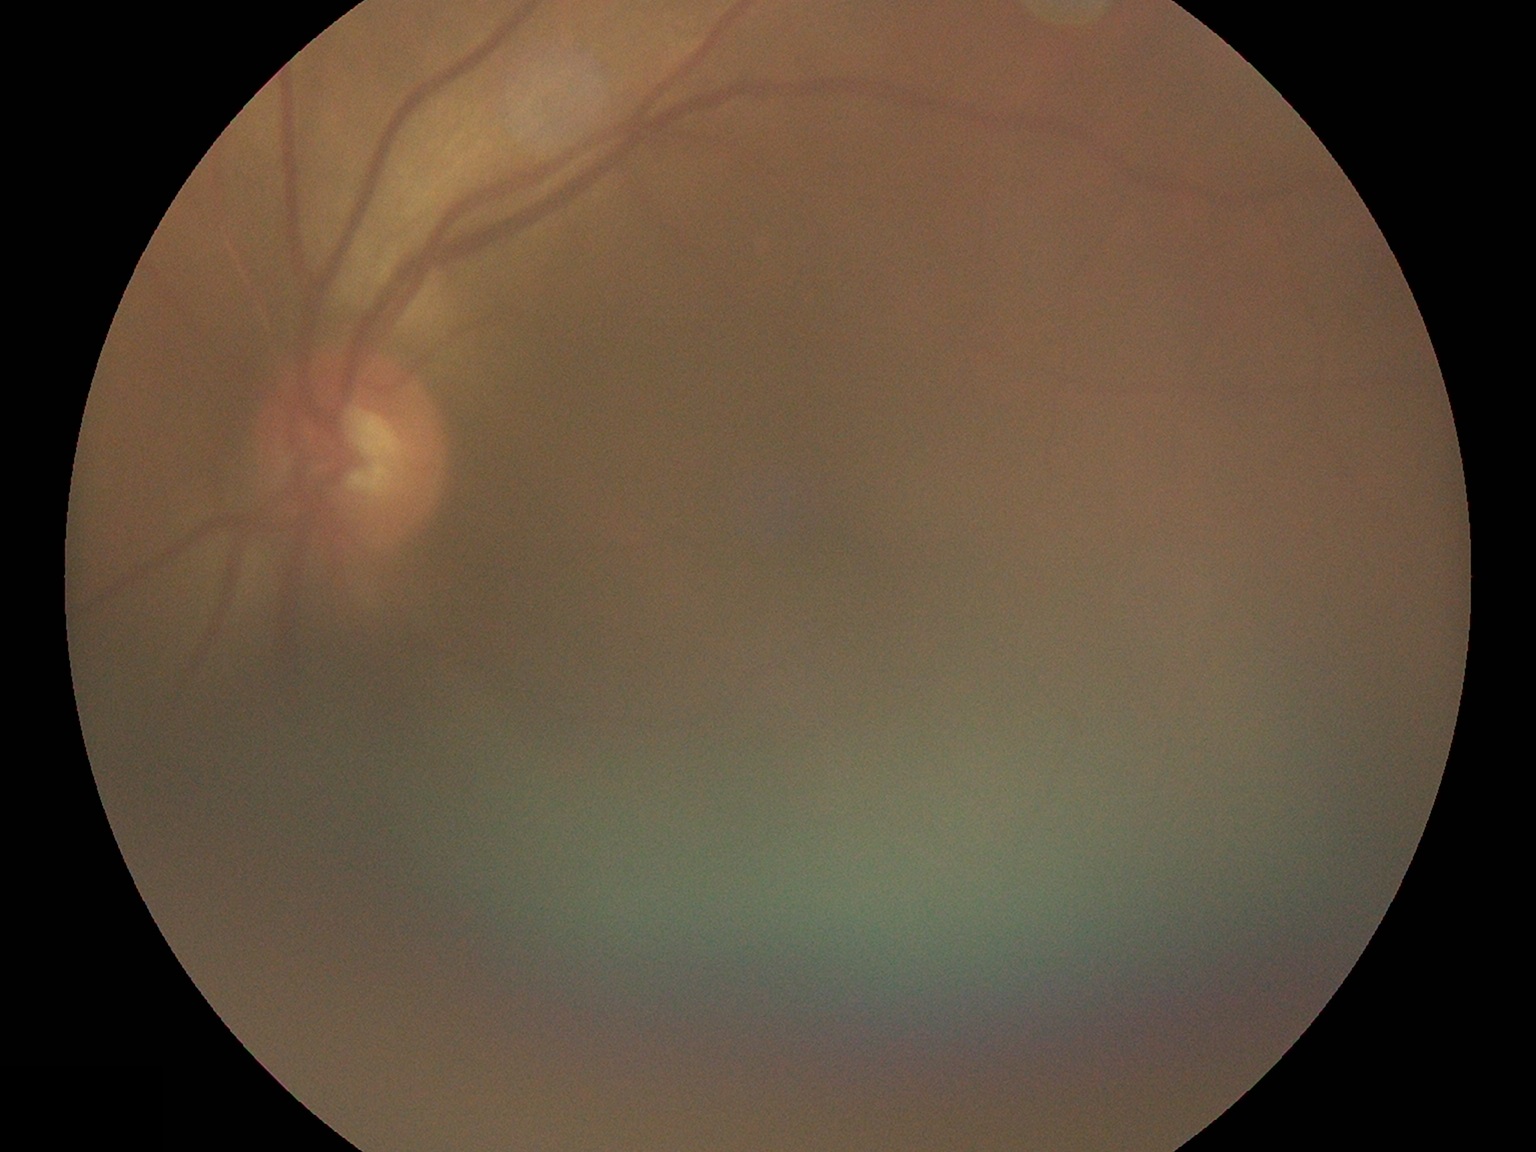

DR impression: no DR findings; diabetic retinopathy (DR): 0/4.